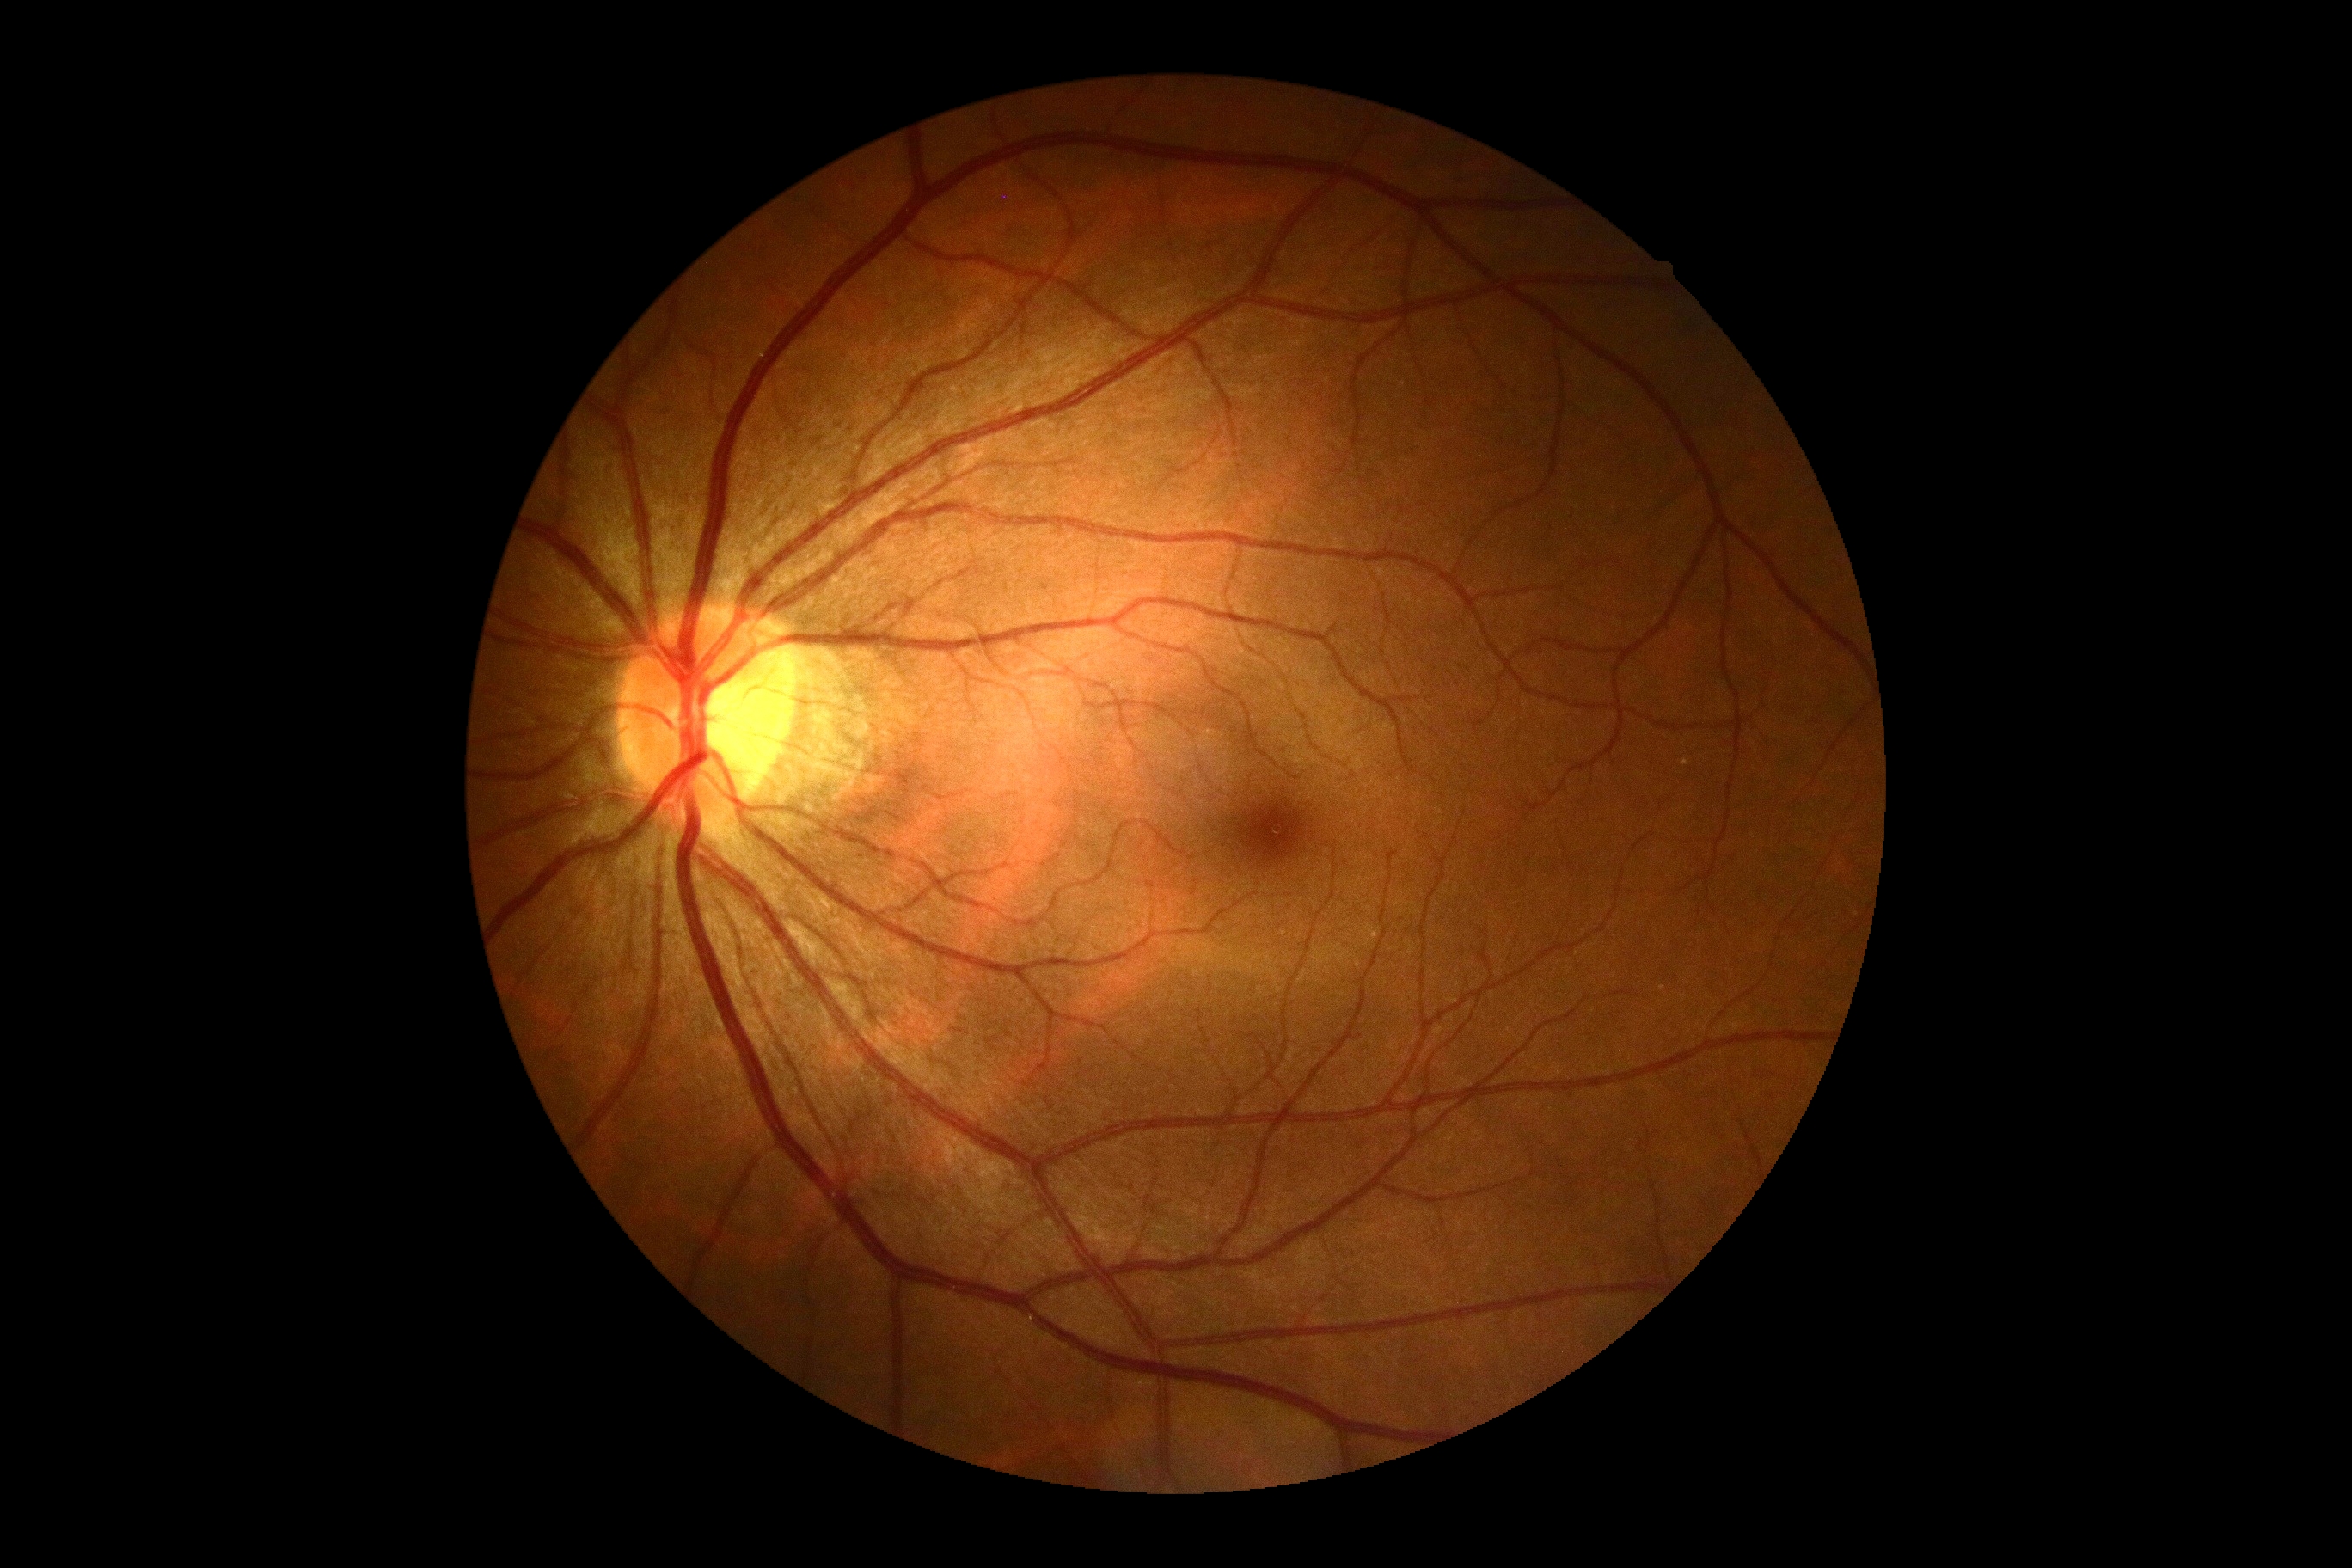
DR impression: no DR findings, diabetic retinopathy (DR): no apparent diabetic retinopathy (grade 0) — no visible signs of diabetic retinopathy.